Image size 848x848. 45-degree field of view. Color fundus photograph. No pharmacologic dilation. Diabetic retinopathy graded by the modified Davis classification. Acquired with a NIDEK AFC-230 — 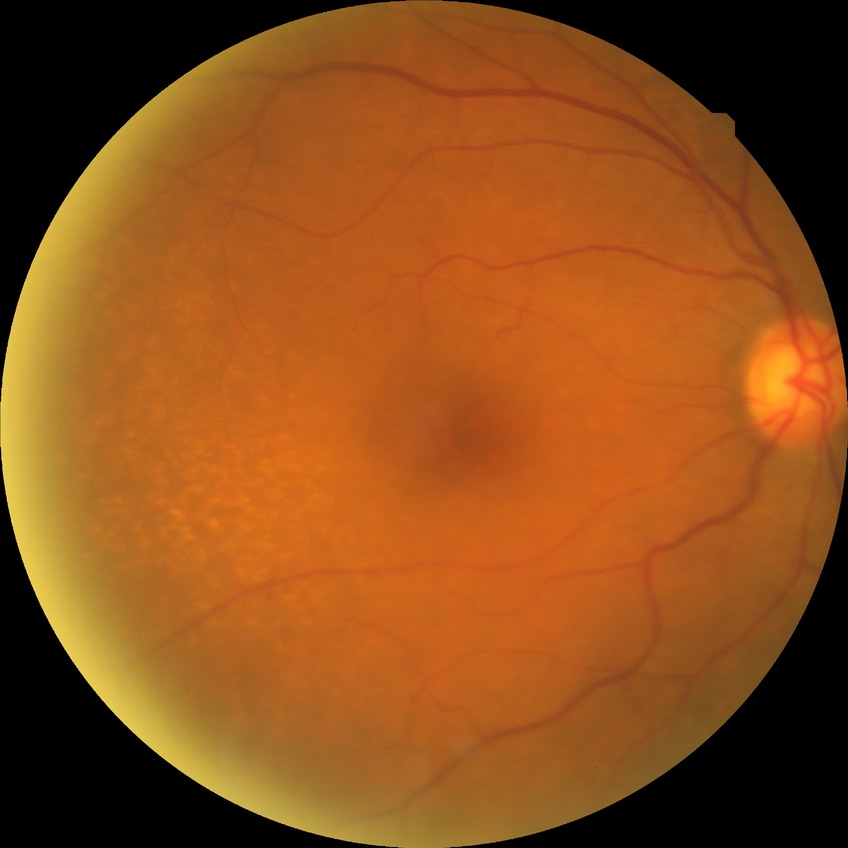
Diabetic retinopathy (DR): no diabetic retinopathy (NDR).